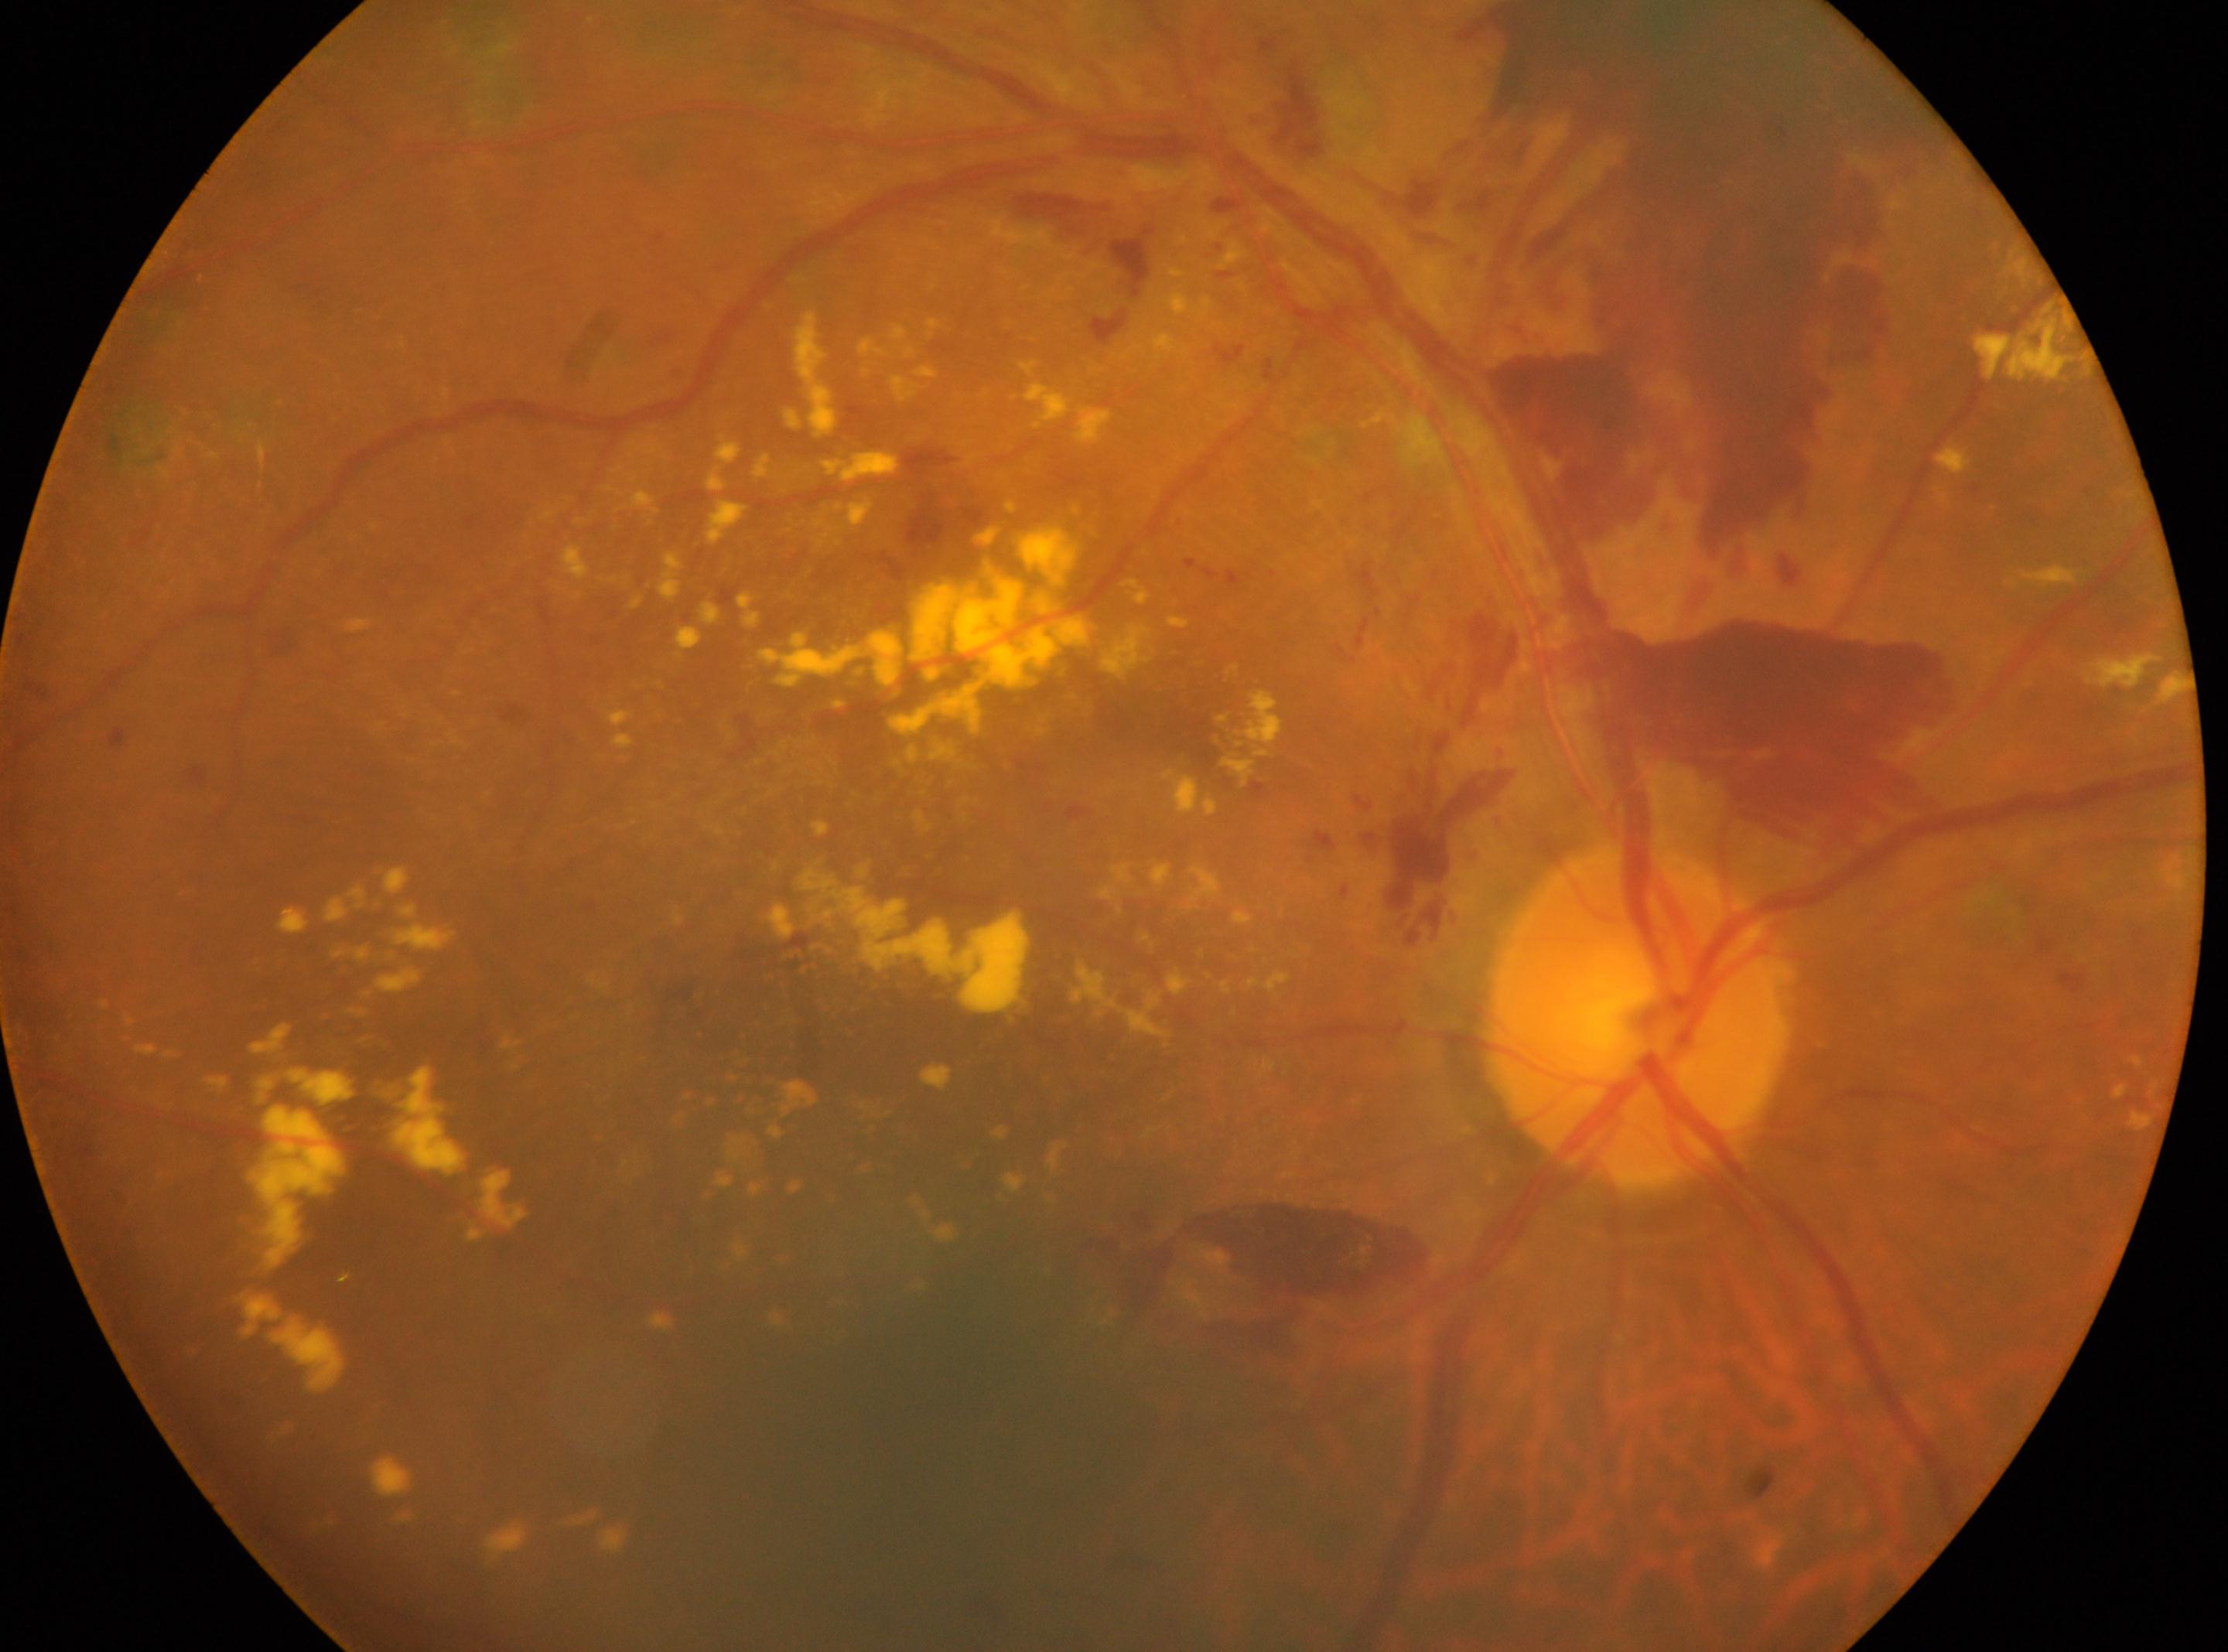

Fovea: (x: 870, y: 1050). Optic disc located at (x: 1637, y: 1017). DR grade: DR with laser photocoagulation scars, with underlying PDR (grade 4). Eye: OD.